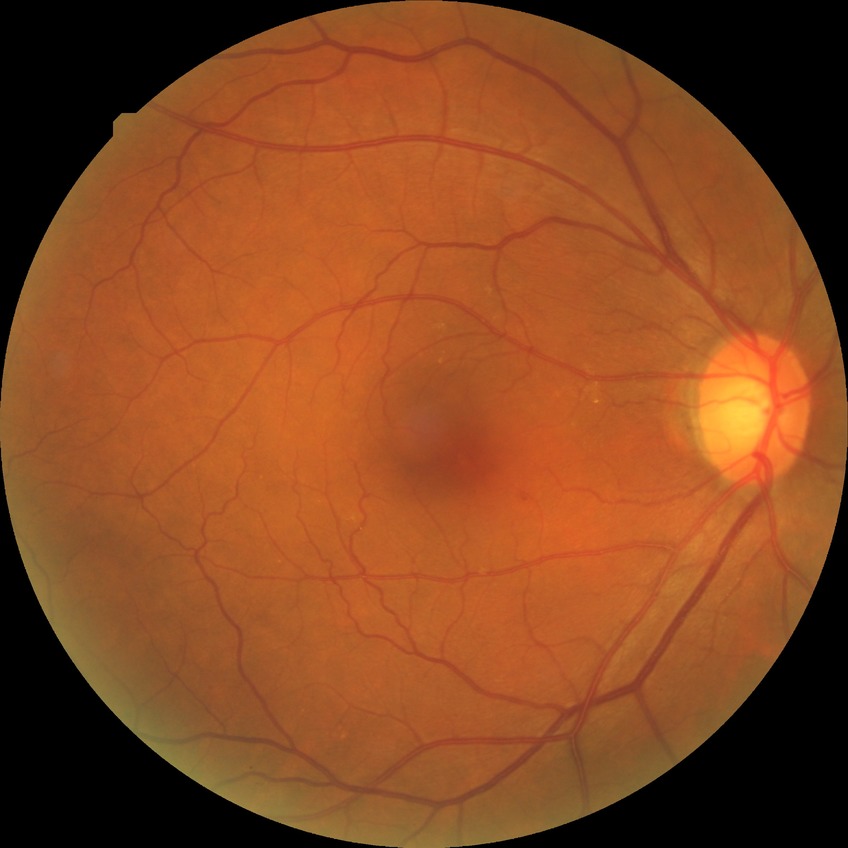 Annotations:
- diabetic retinopathy (DR): no diabetic retinopathy (NDR)